CFP.
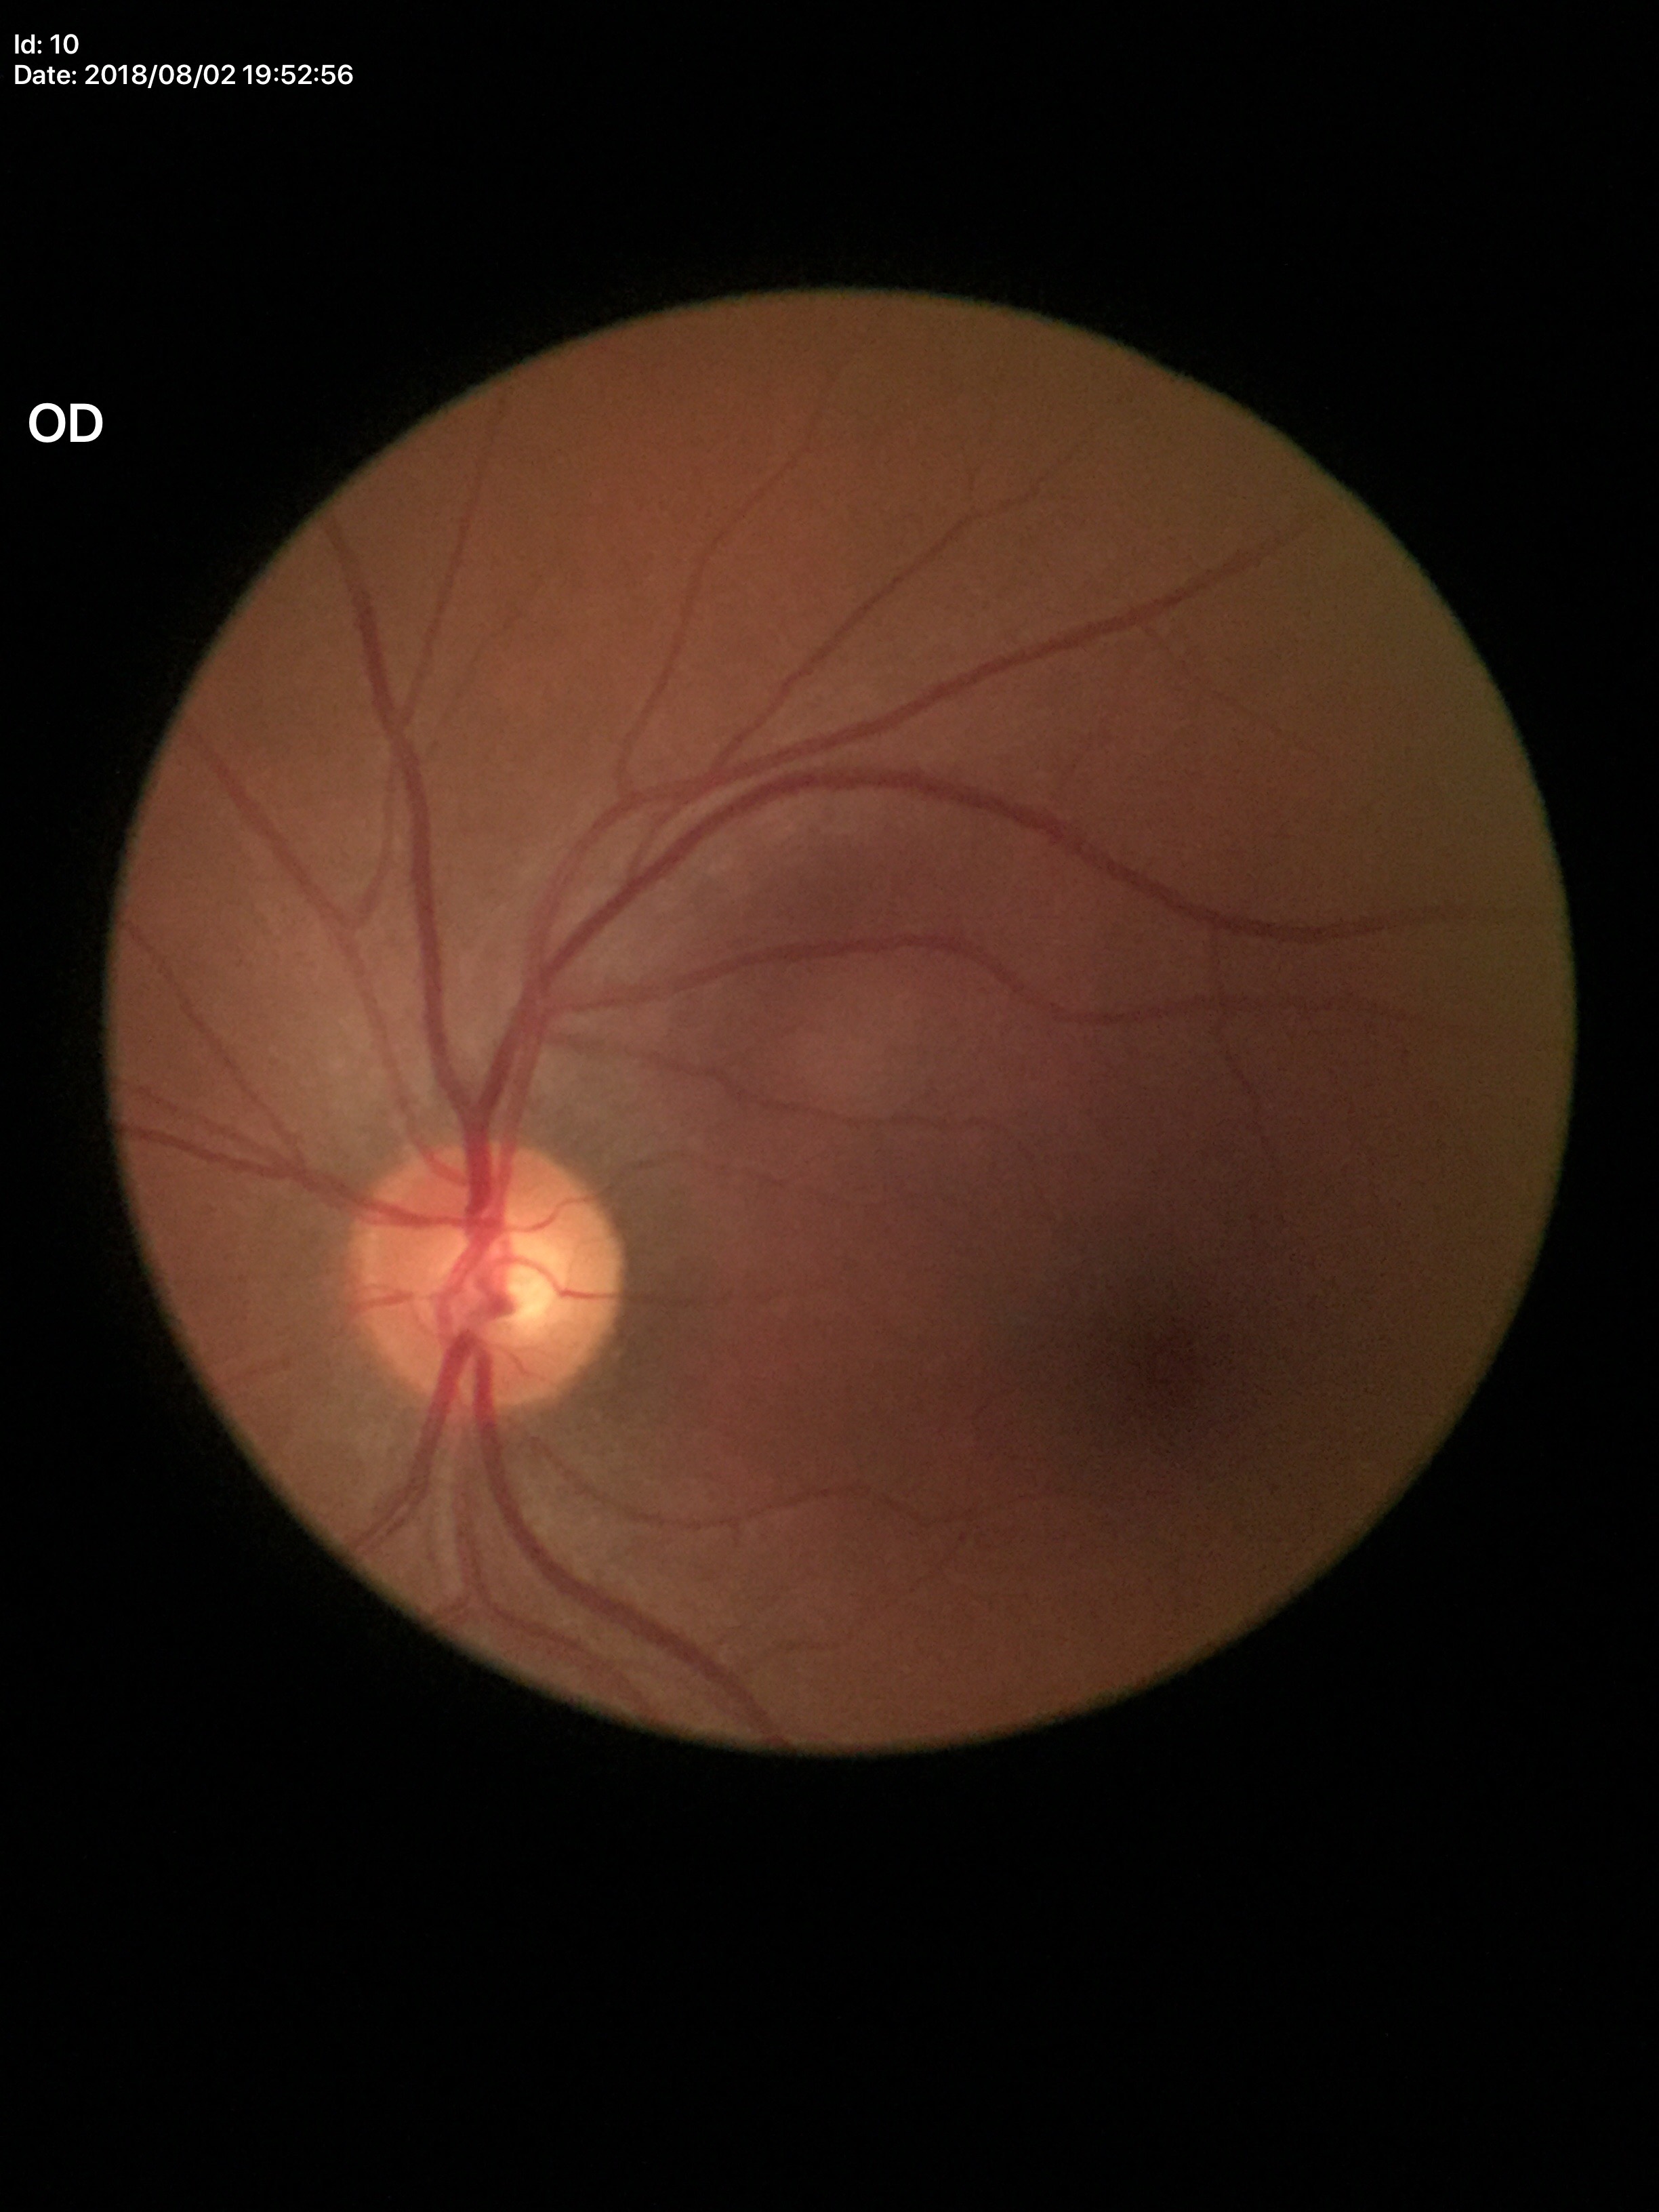
Glaucoma decision=negative; vertical cup-to-disc ratio=0.50